NIDEK AFC-230 fundus camera; FOV: 45 degrees; CFP
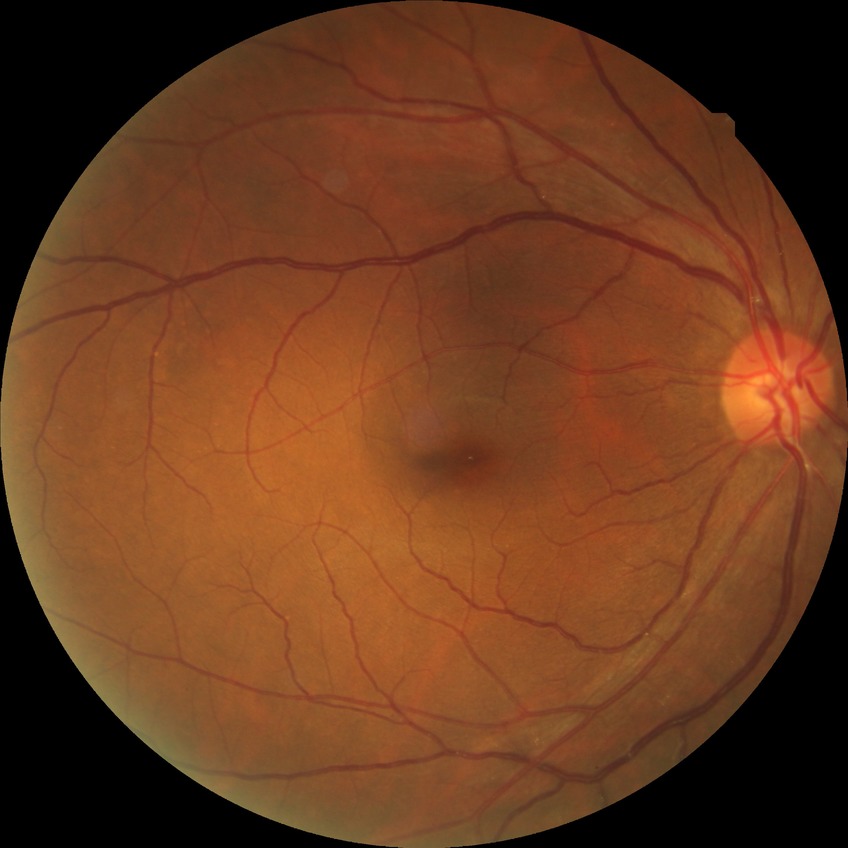

Diabetic retinopathy grade: no diabetic retinopathy.